Pediatric wide-field fundus photograph. Image size 1240x1240 — 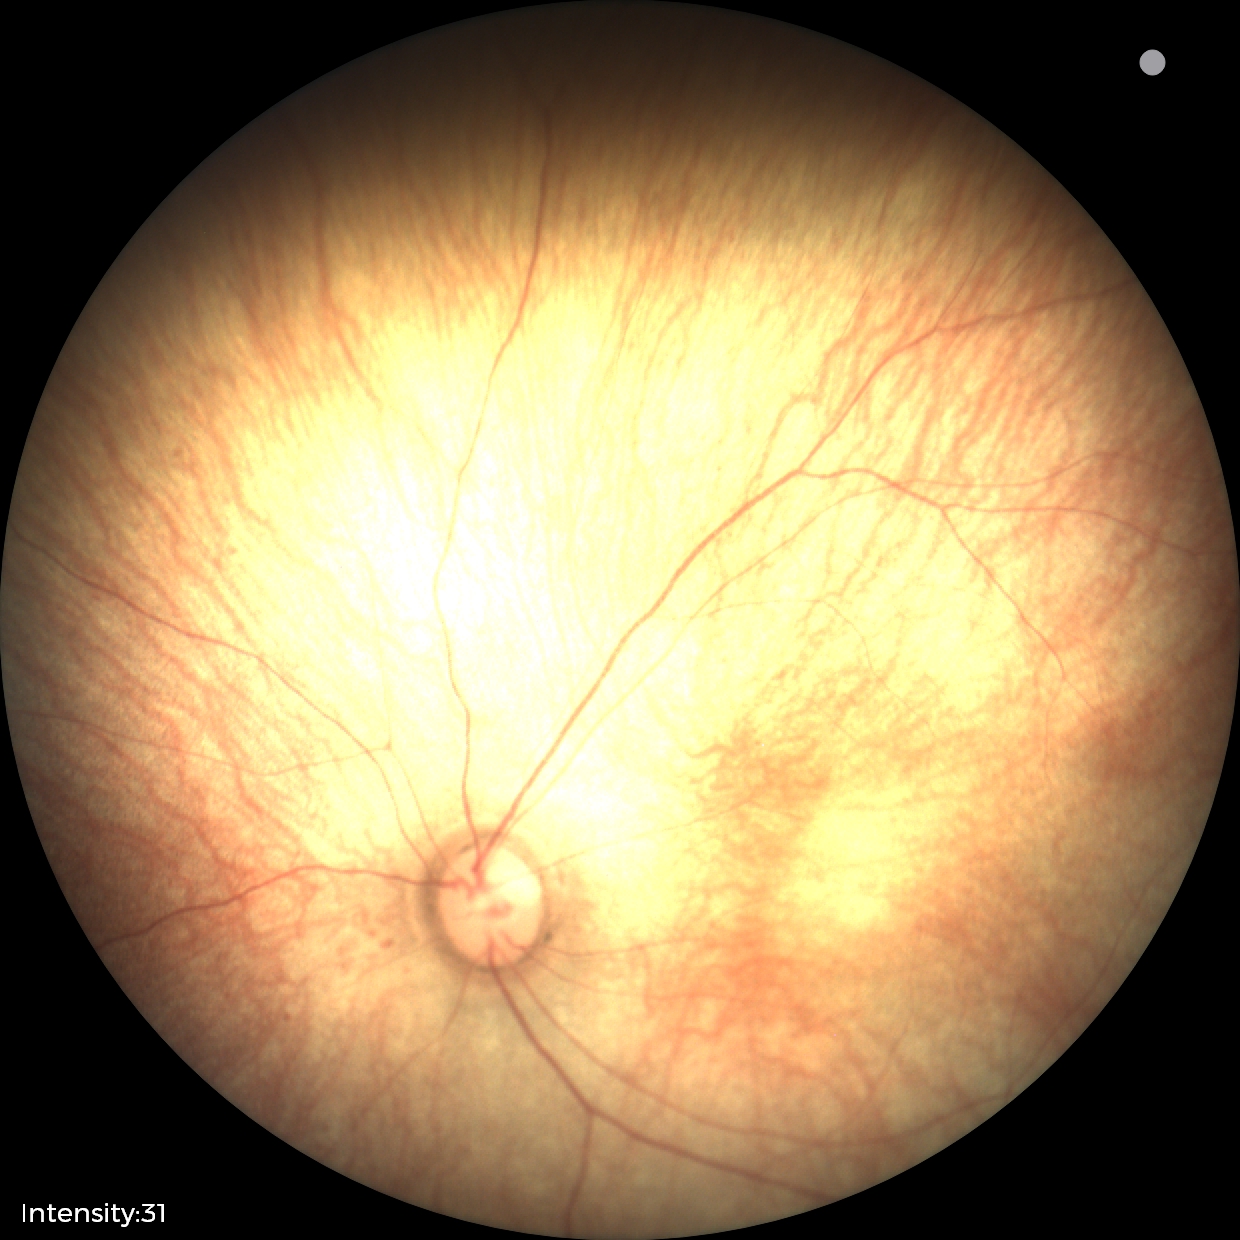

Normal screening examination.